848x848. Posterior pole color fundus photograph. DR severity per modified Davis staging. Acquired with a NIDEK AFC-230. Nonmydriatic
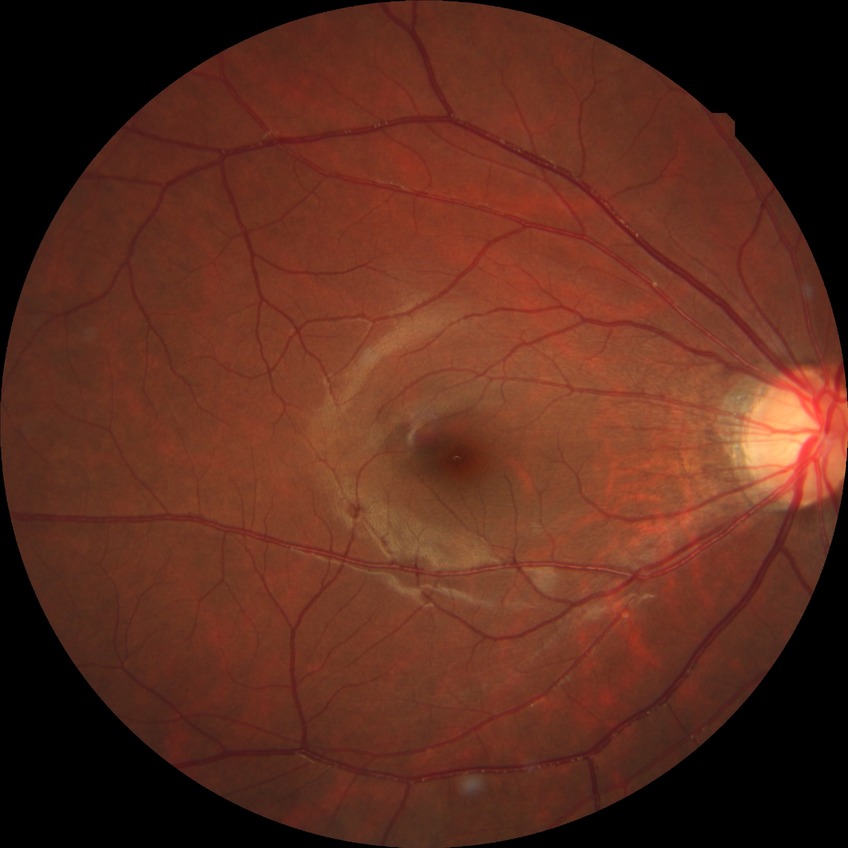

DR severity is NDR.